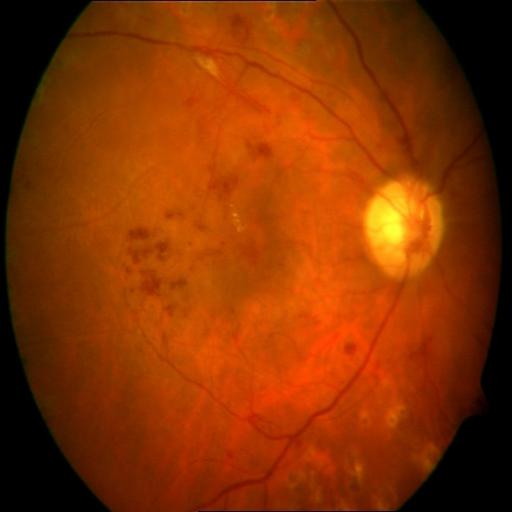
Pathology:
- hemorrhagic retinopathy (HR)